2212x1659 · 45° field of view · fundus photo: 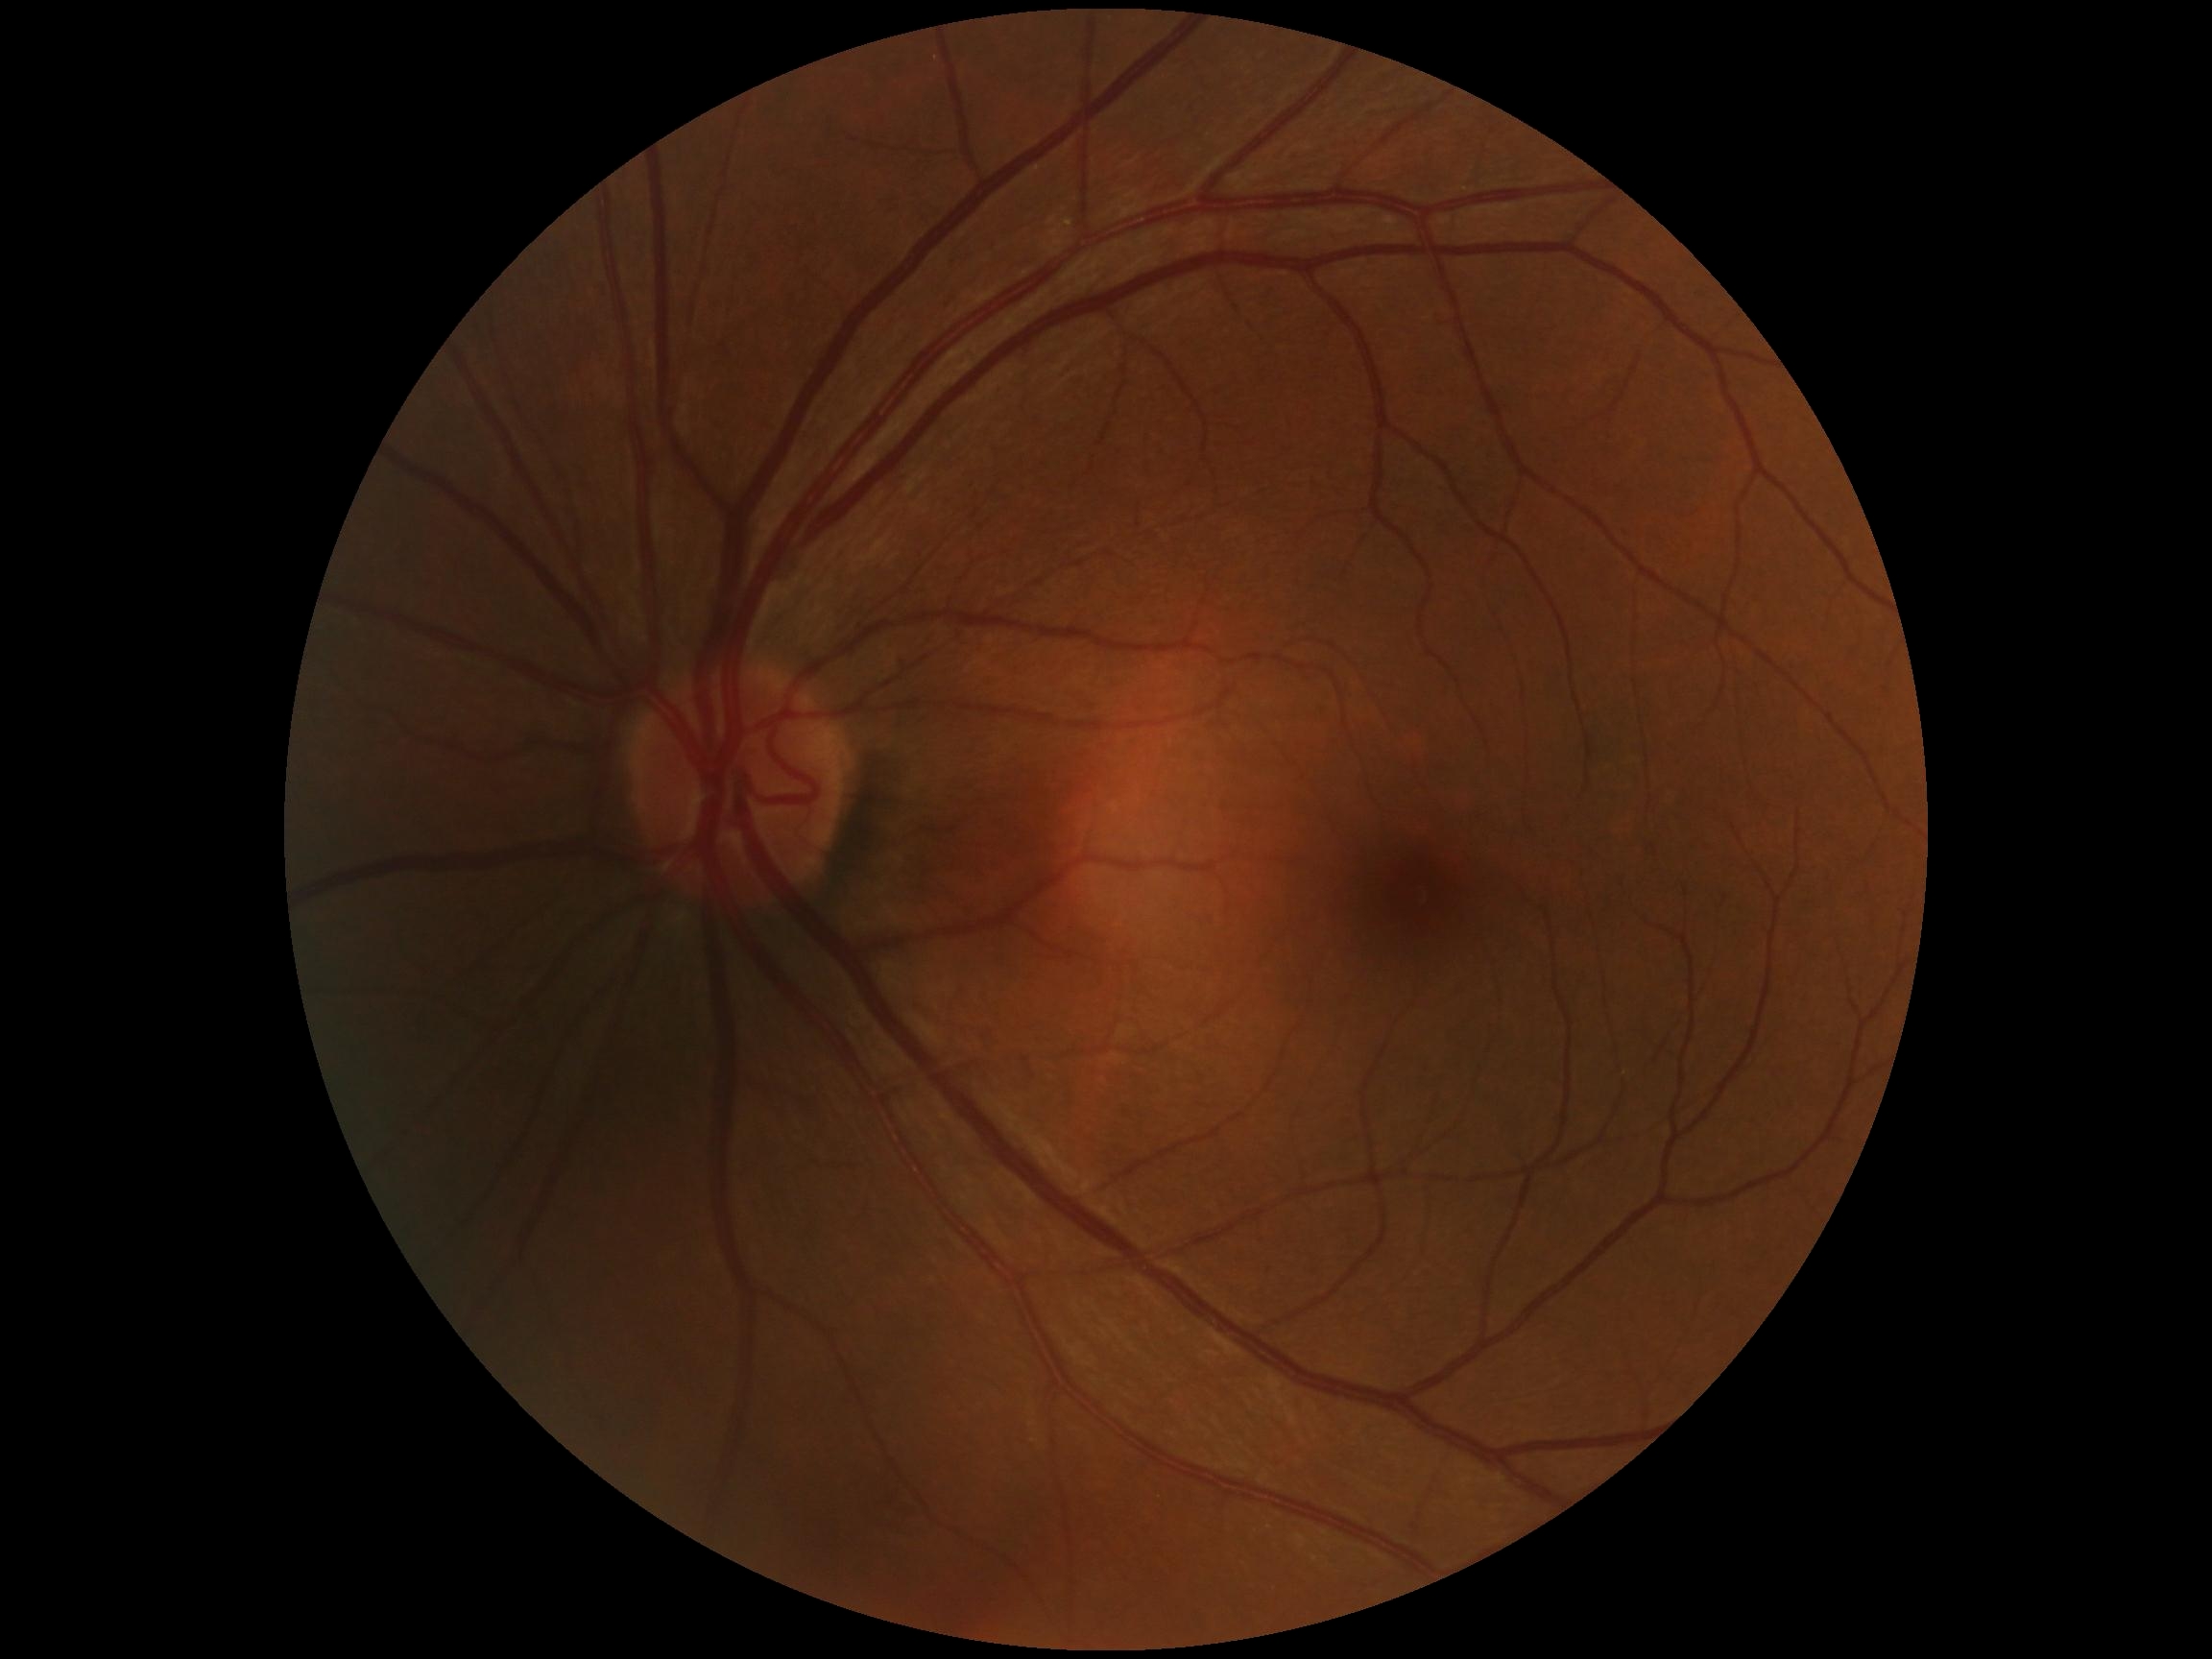
Retinopathy: no apparent retinopathy (grade 0).